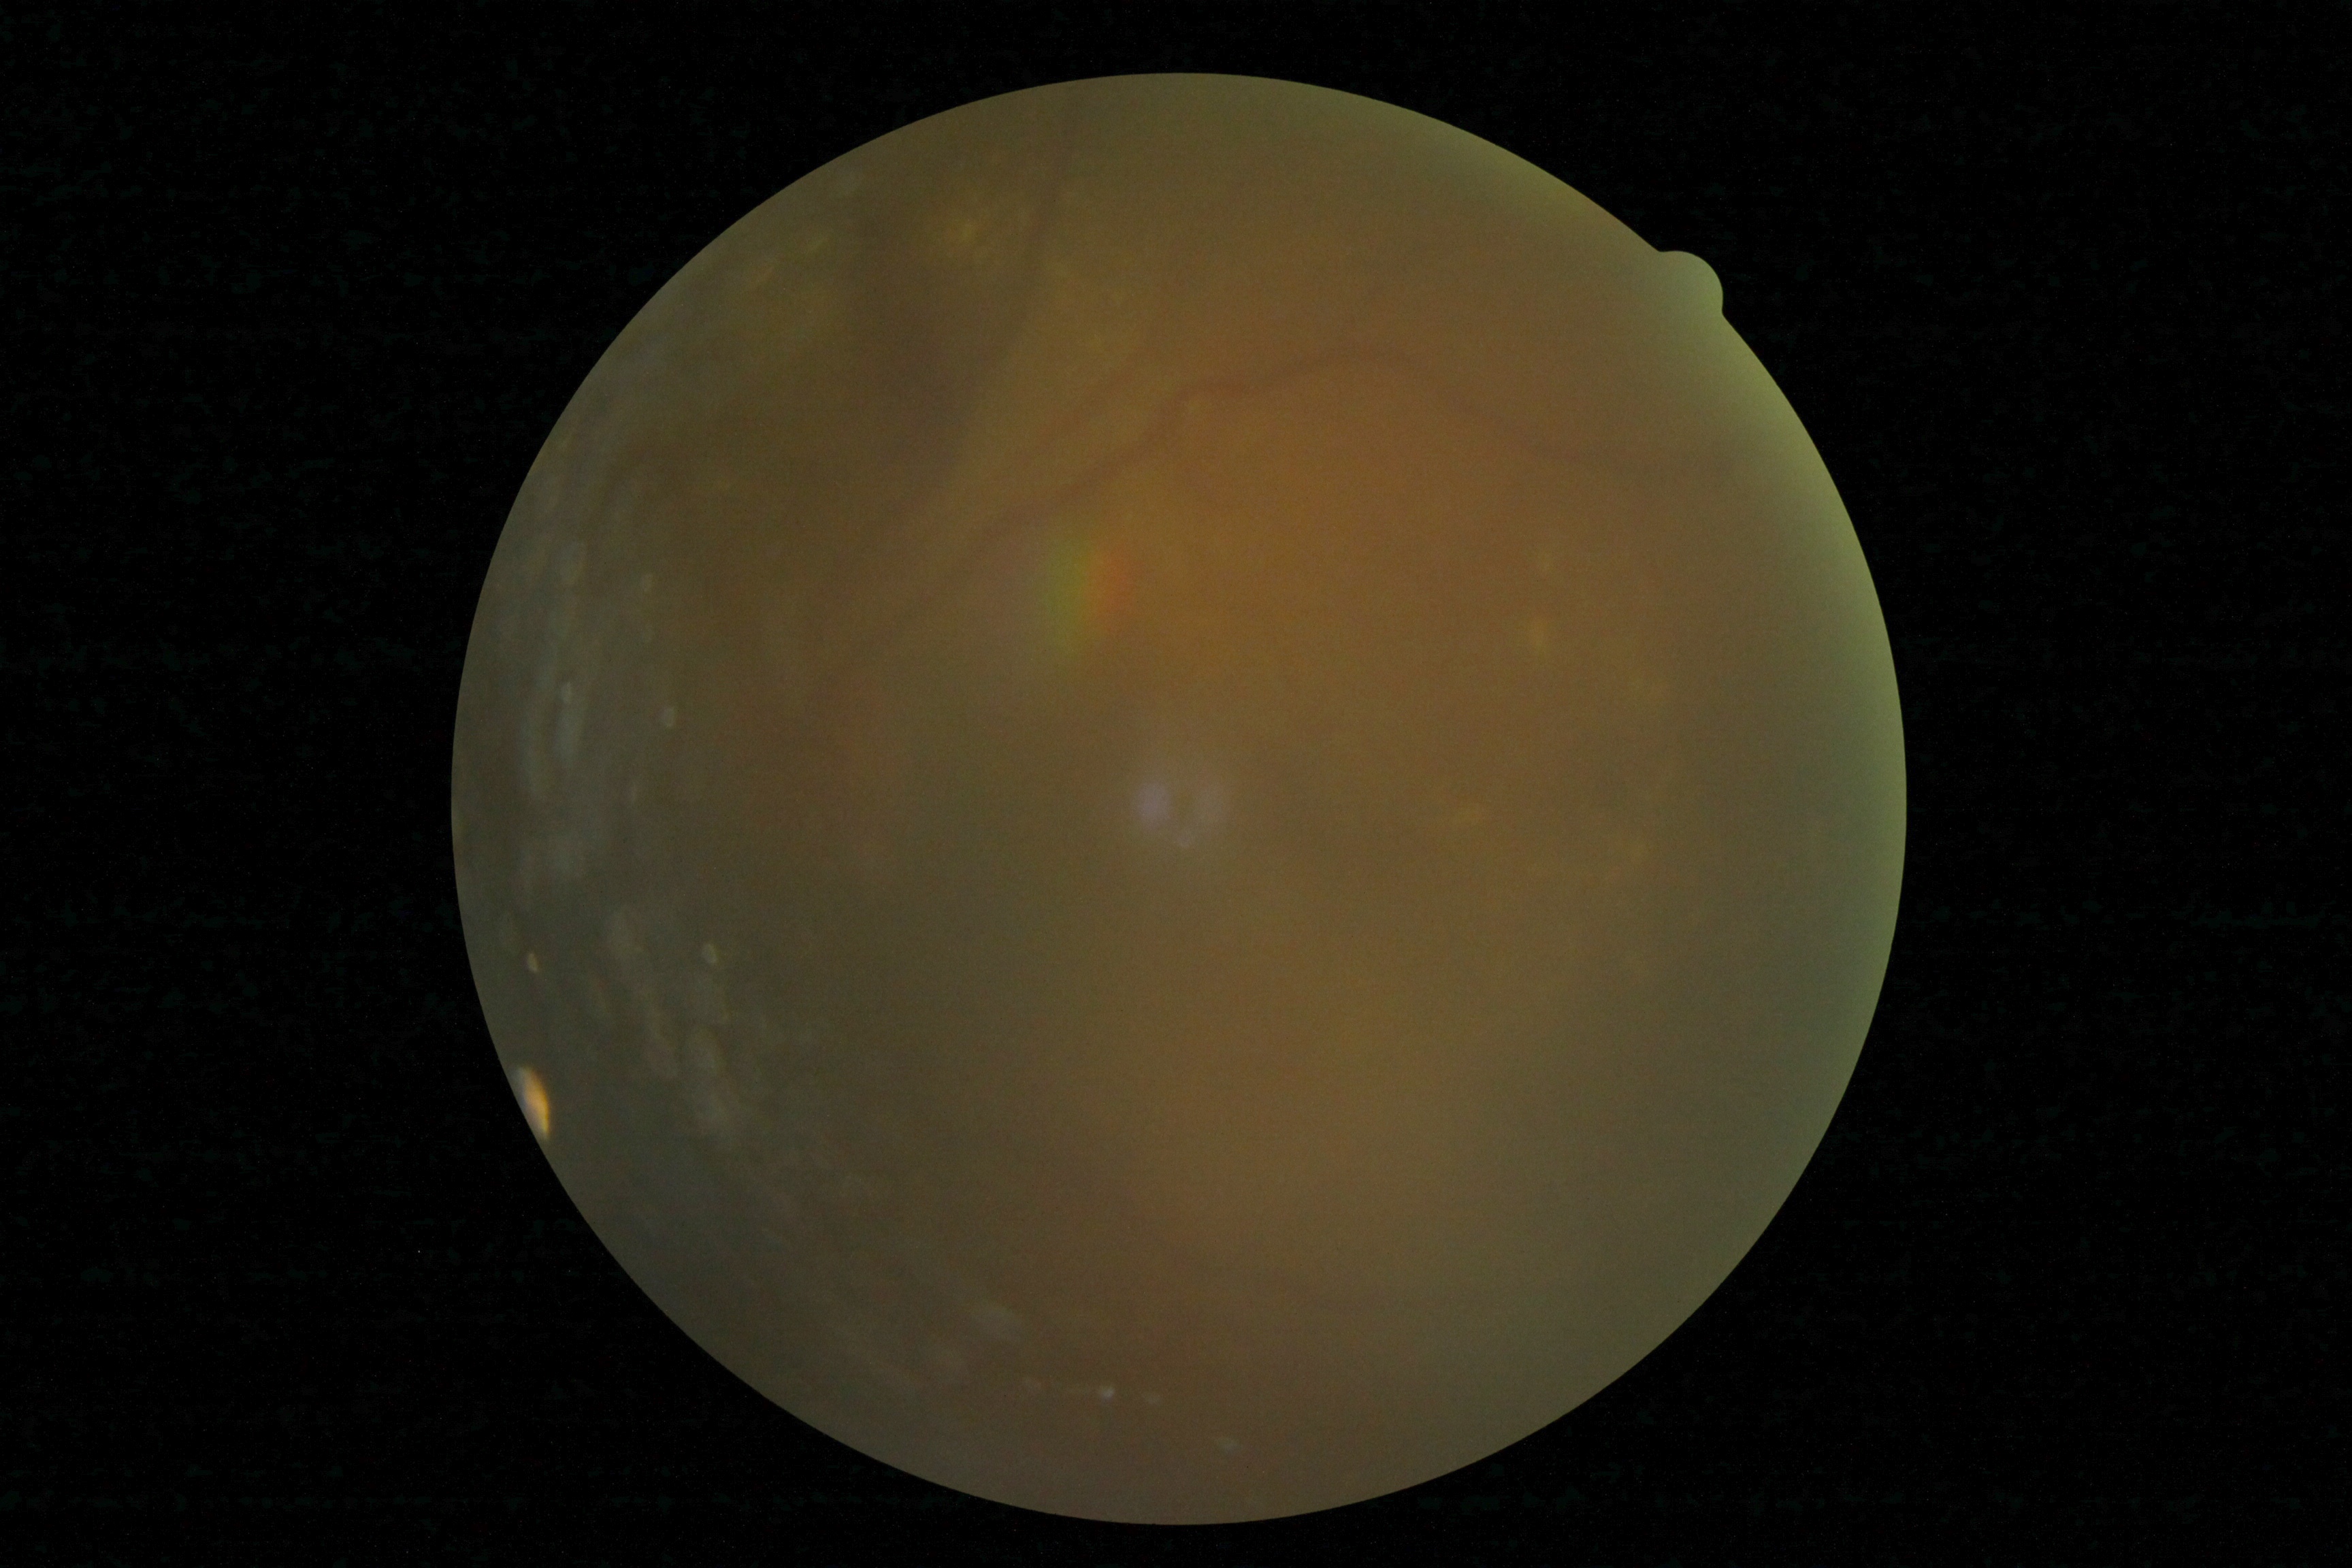 image quality: below grading threshold, diabetic retinopathy (DR): ungradable.